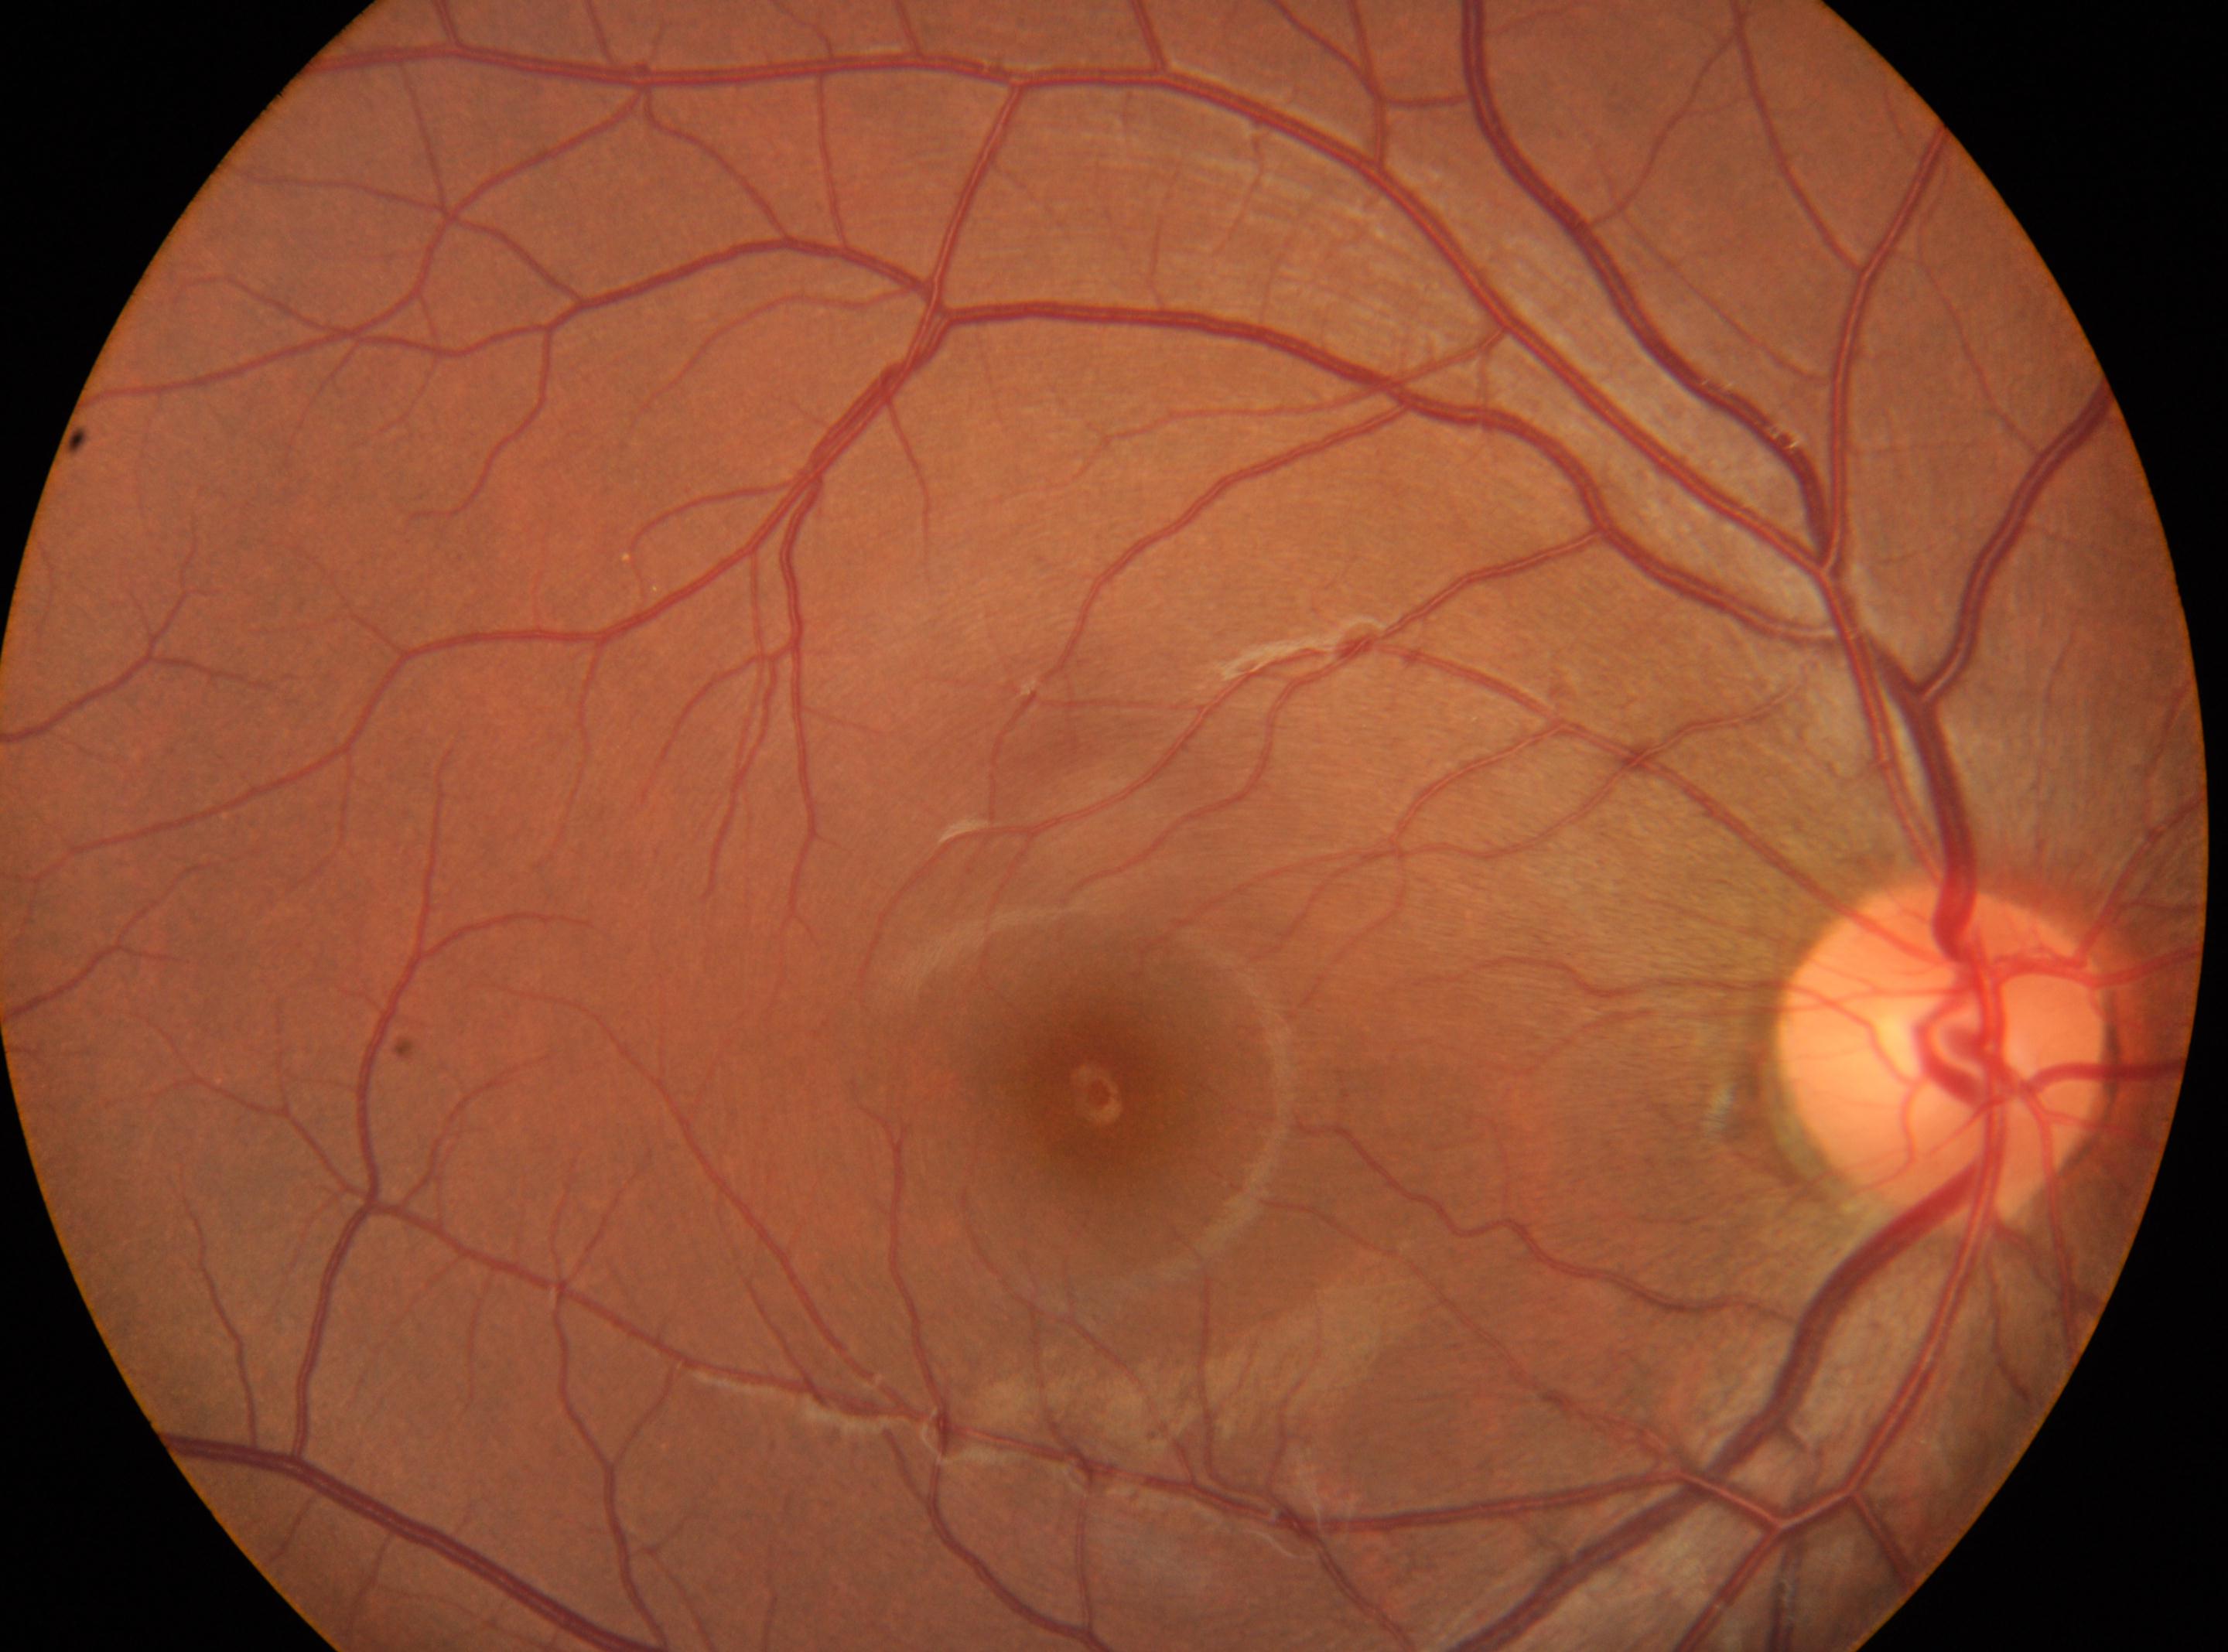

Disc center located at (1941, 1050). DR stage is no apparent diabetic retinopathy (grade 0). Fovea located at (1097, 1094). Imaged eye: the right eye.